Ultra-widefield fundus mosaic
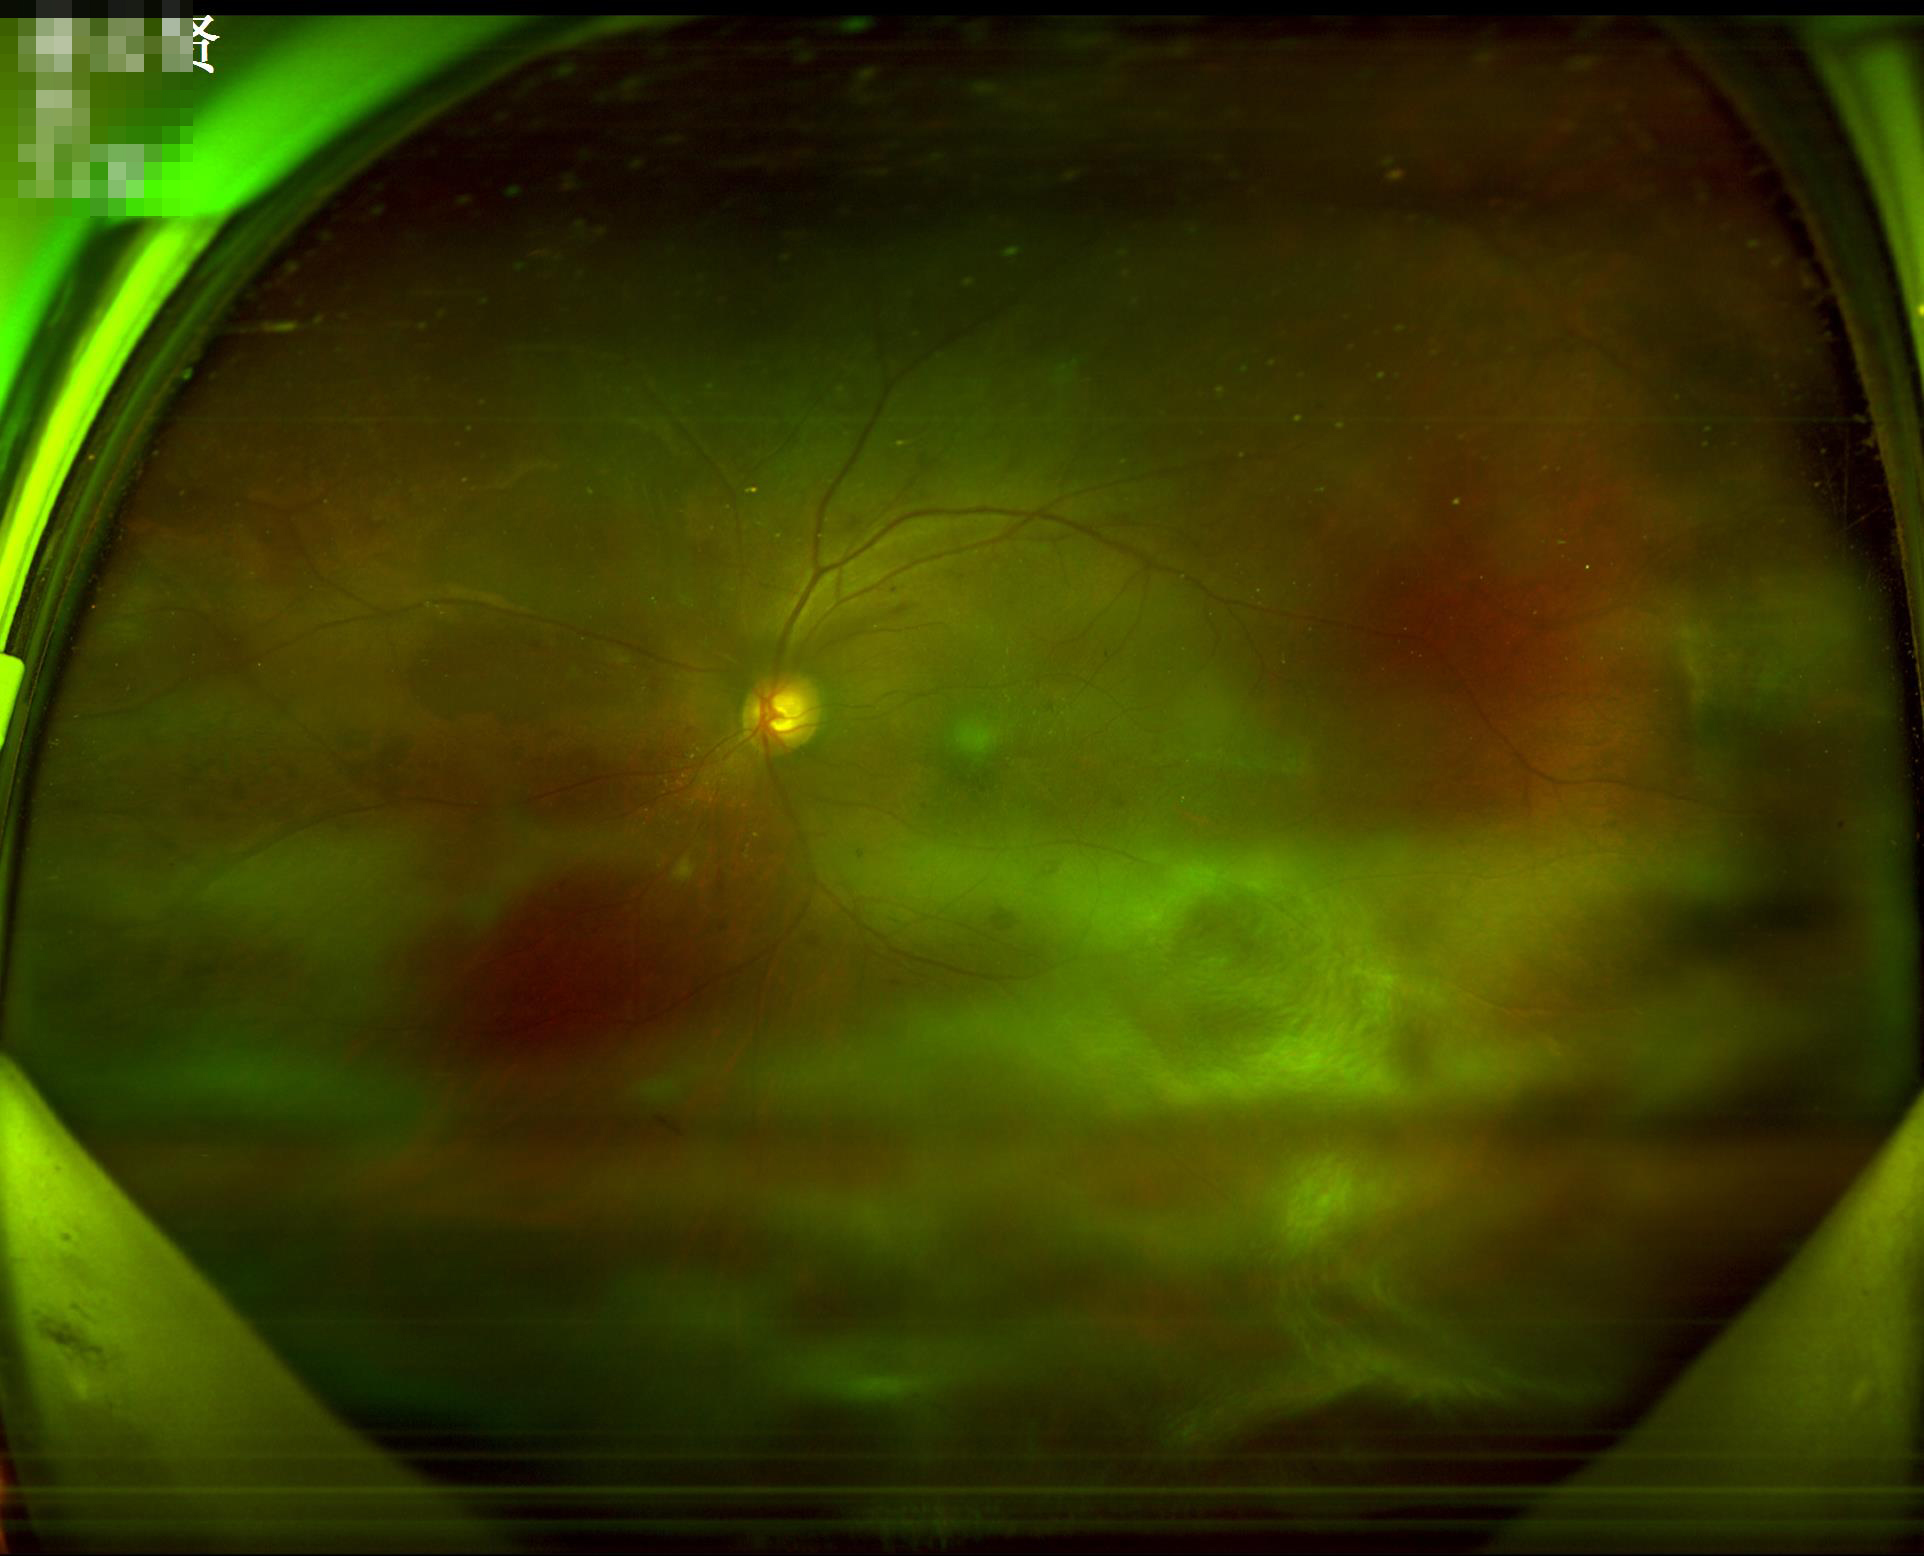

Out of focus; structures are indistinct.
Contrast is good.
Image quality is adequate for diagnostic use.